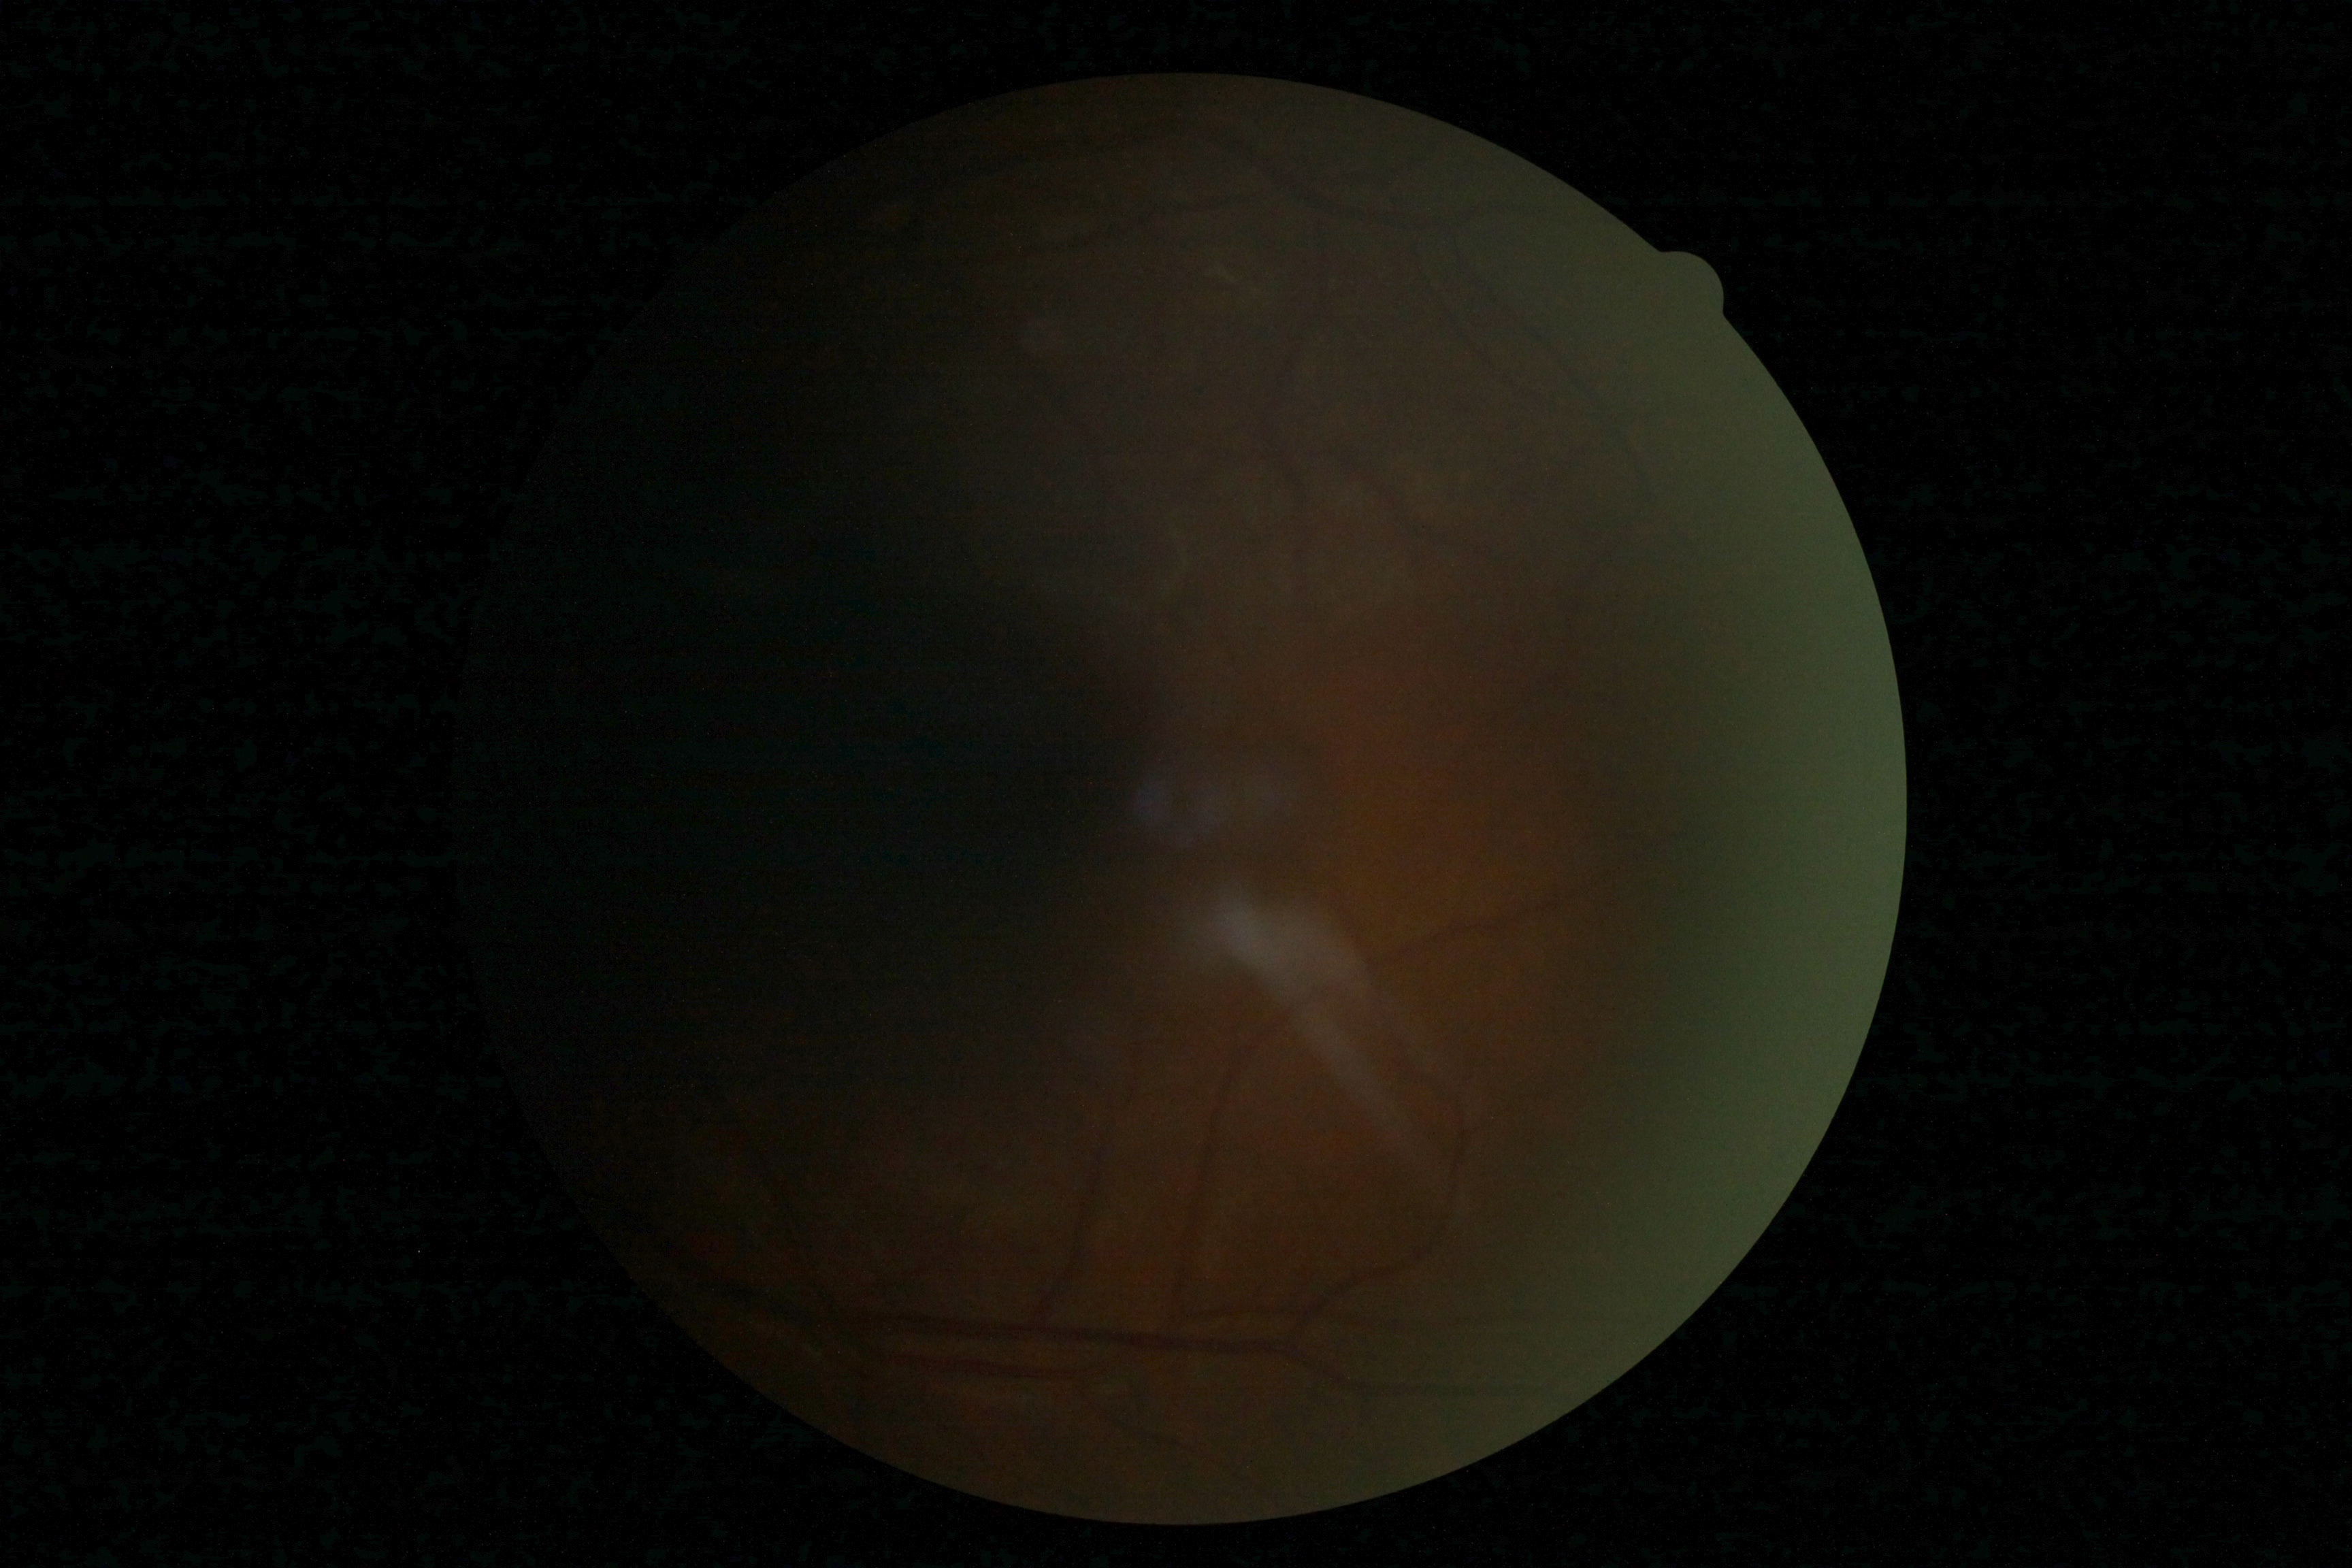

- image quality — insufficient for DR assessment
- DR stage — ungradable due to poor image quality